Phoenix ICON, 100° FOV · Phoenix ICON wide-field infant fundus image: 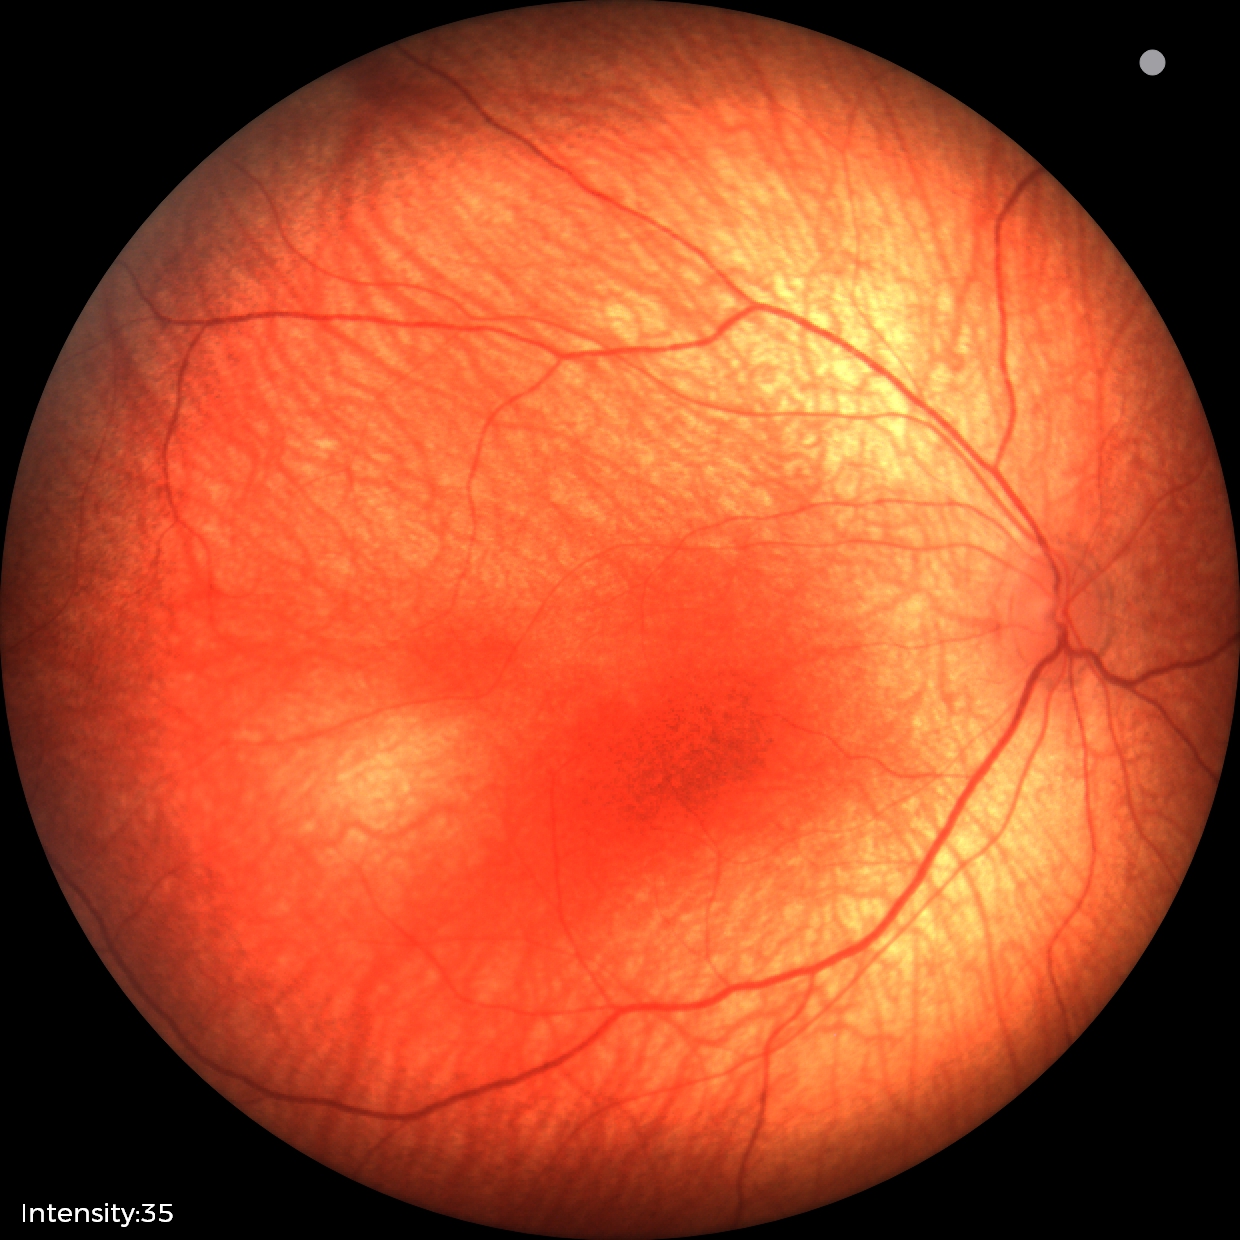

No retinal pathology identified on screening.